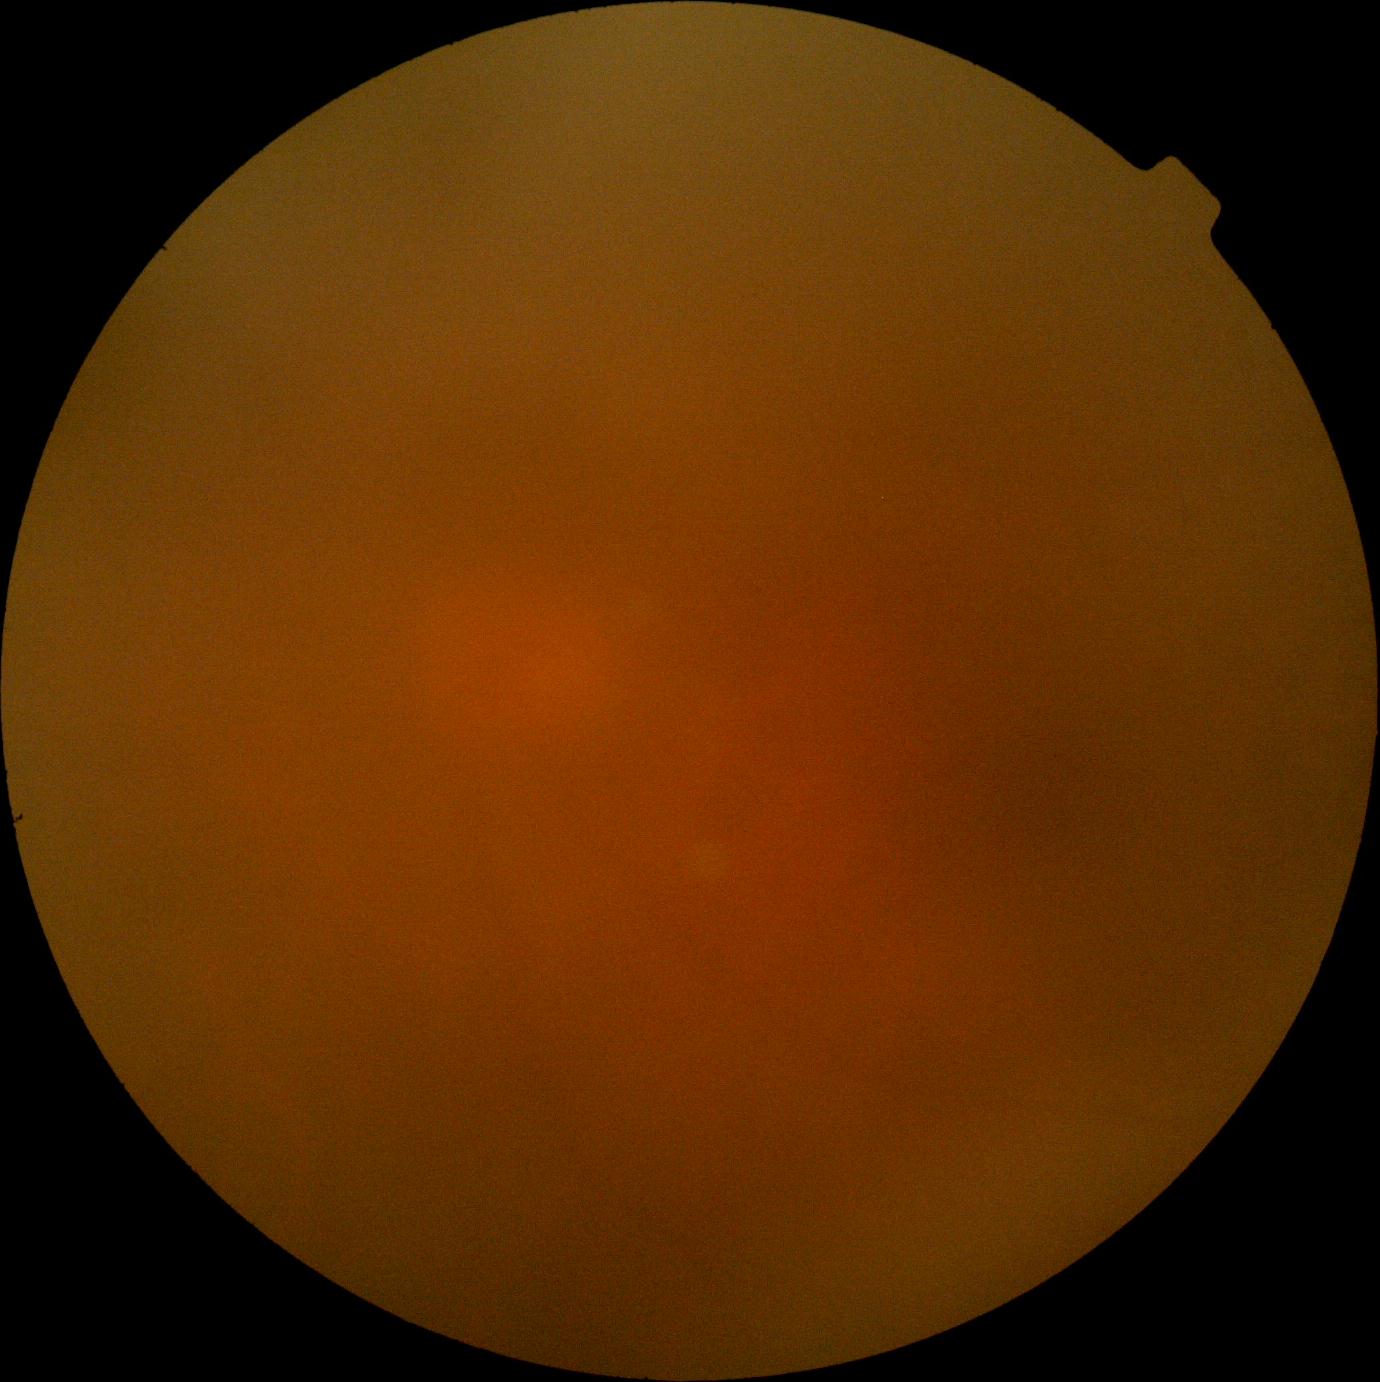 image quality=insufficient, diabetic retinopathy grade=ungradable.